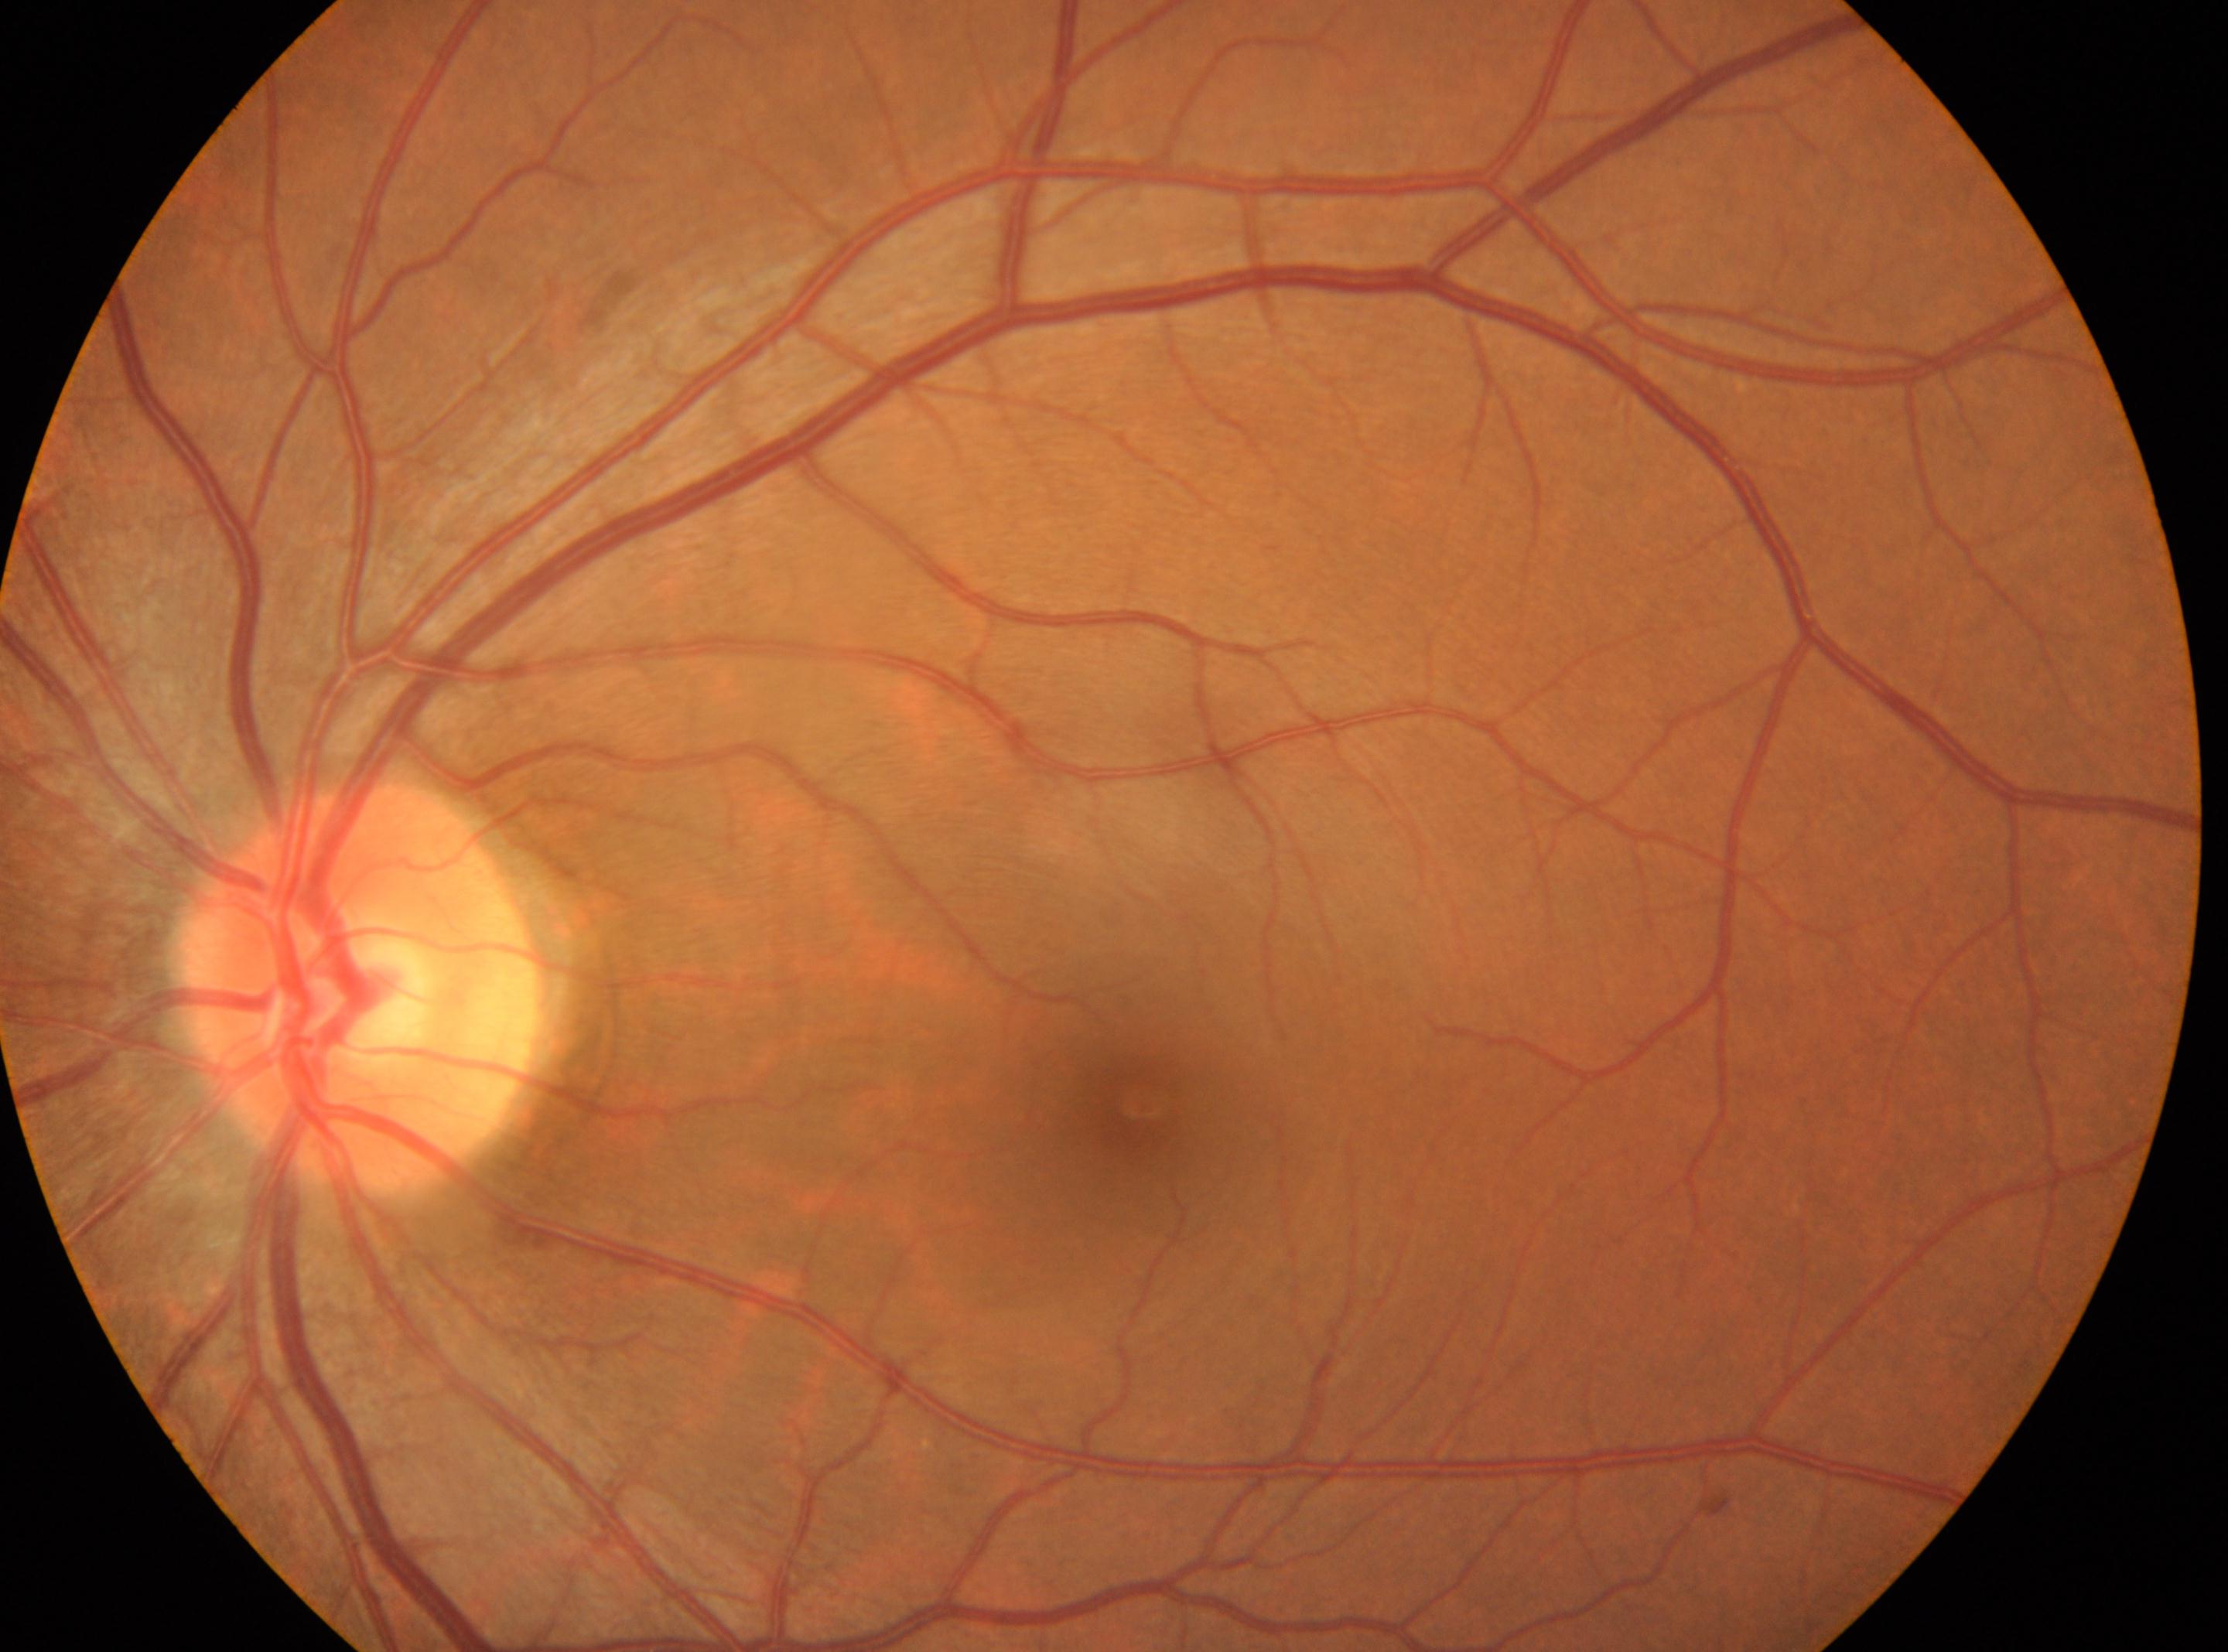
macula center=x=1140, y=1106
the optic disc=x=357, y=990
DR stage=grade 0
OS